Color fundus photograph: 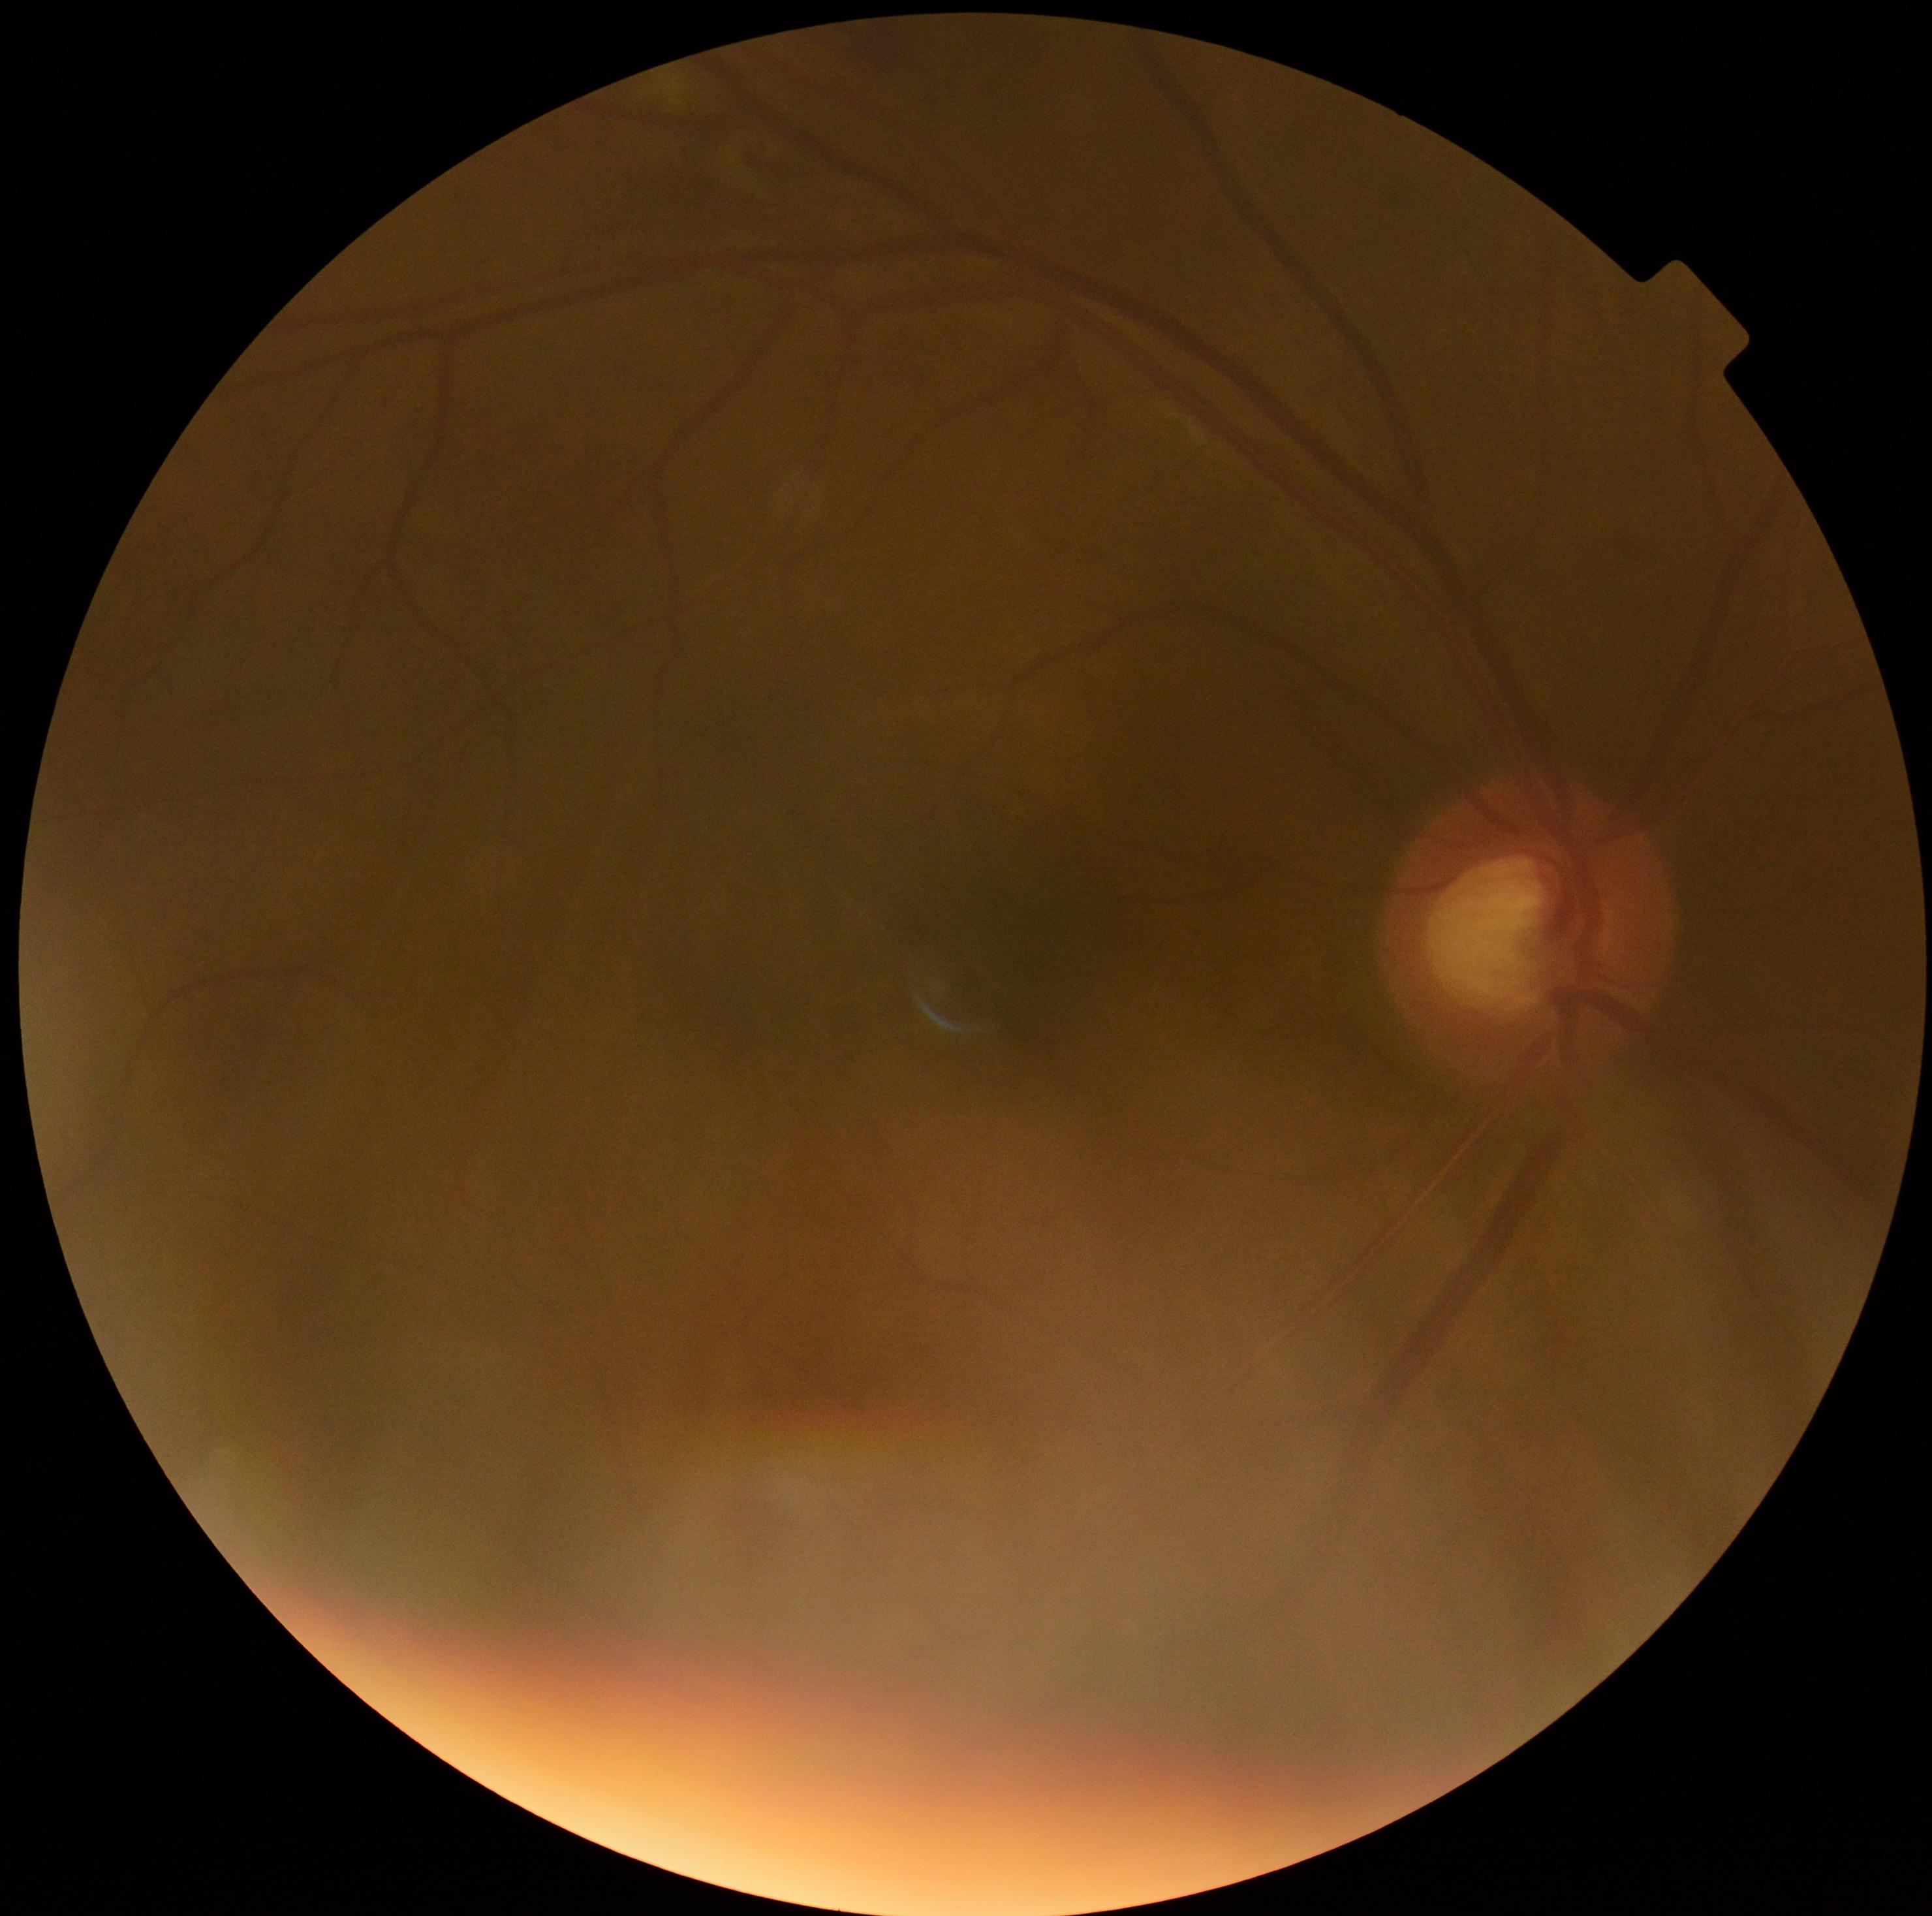

DR severity = grade 2.